Ultra-widefield (UWF) fundus image — 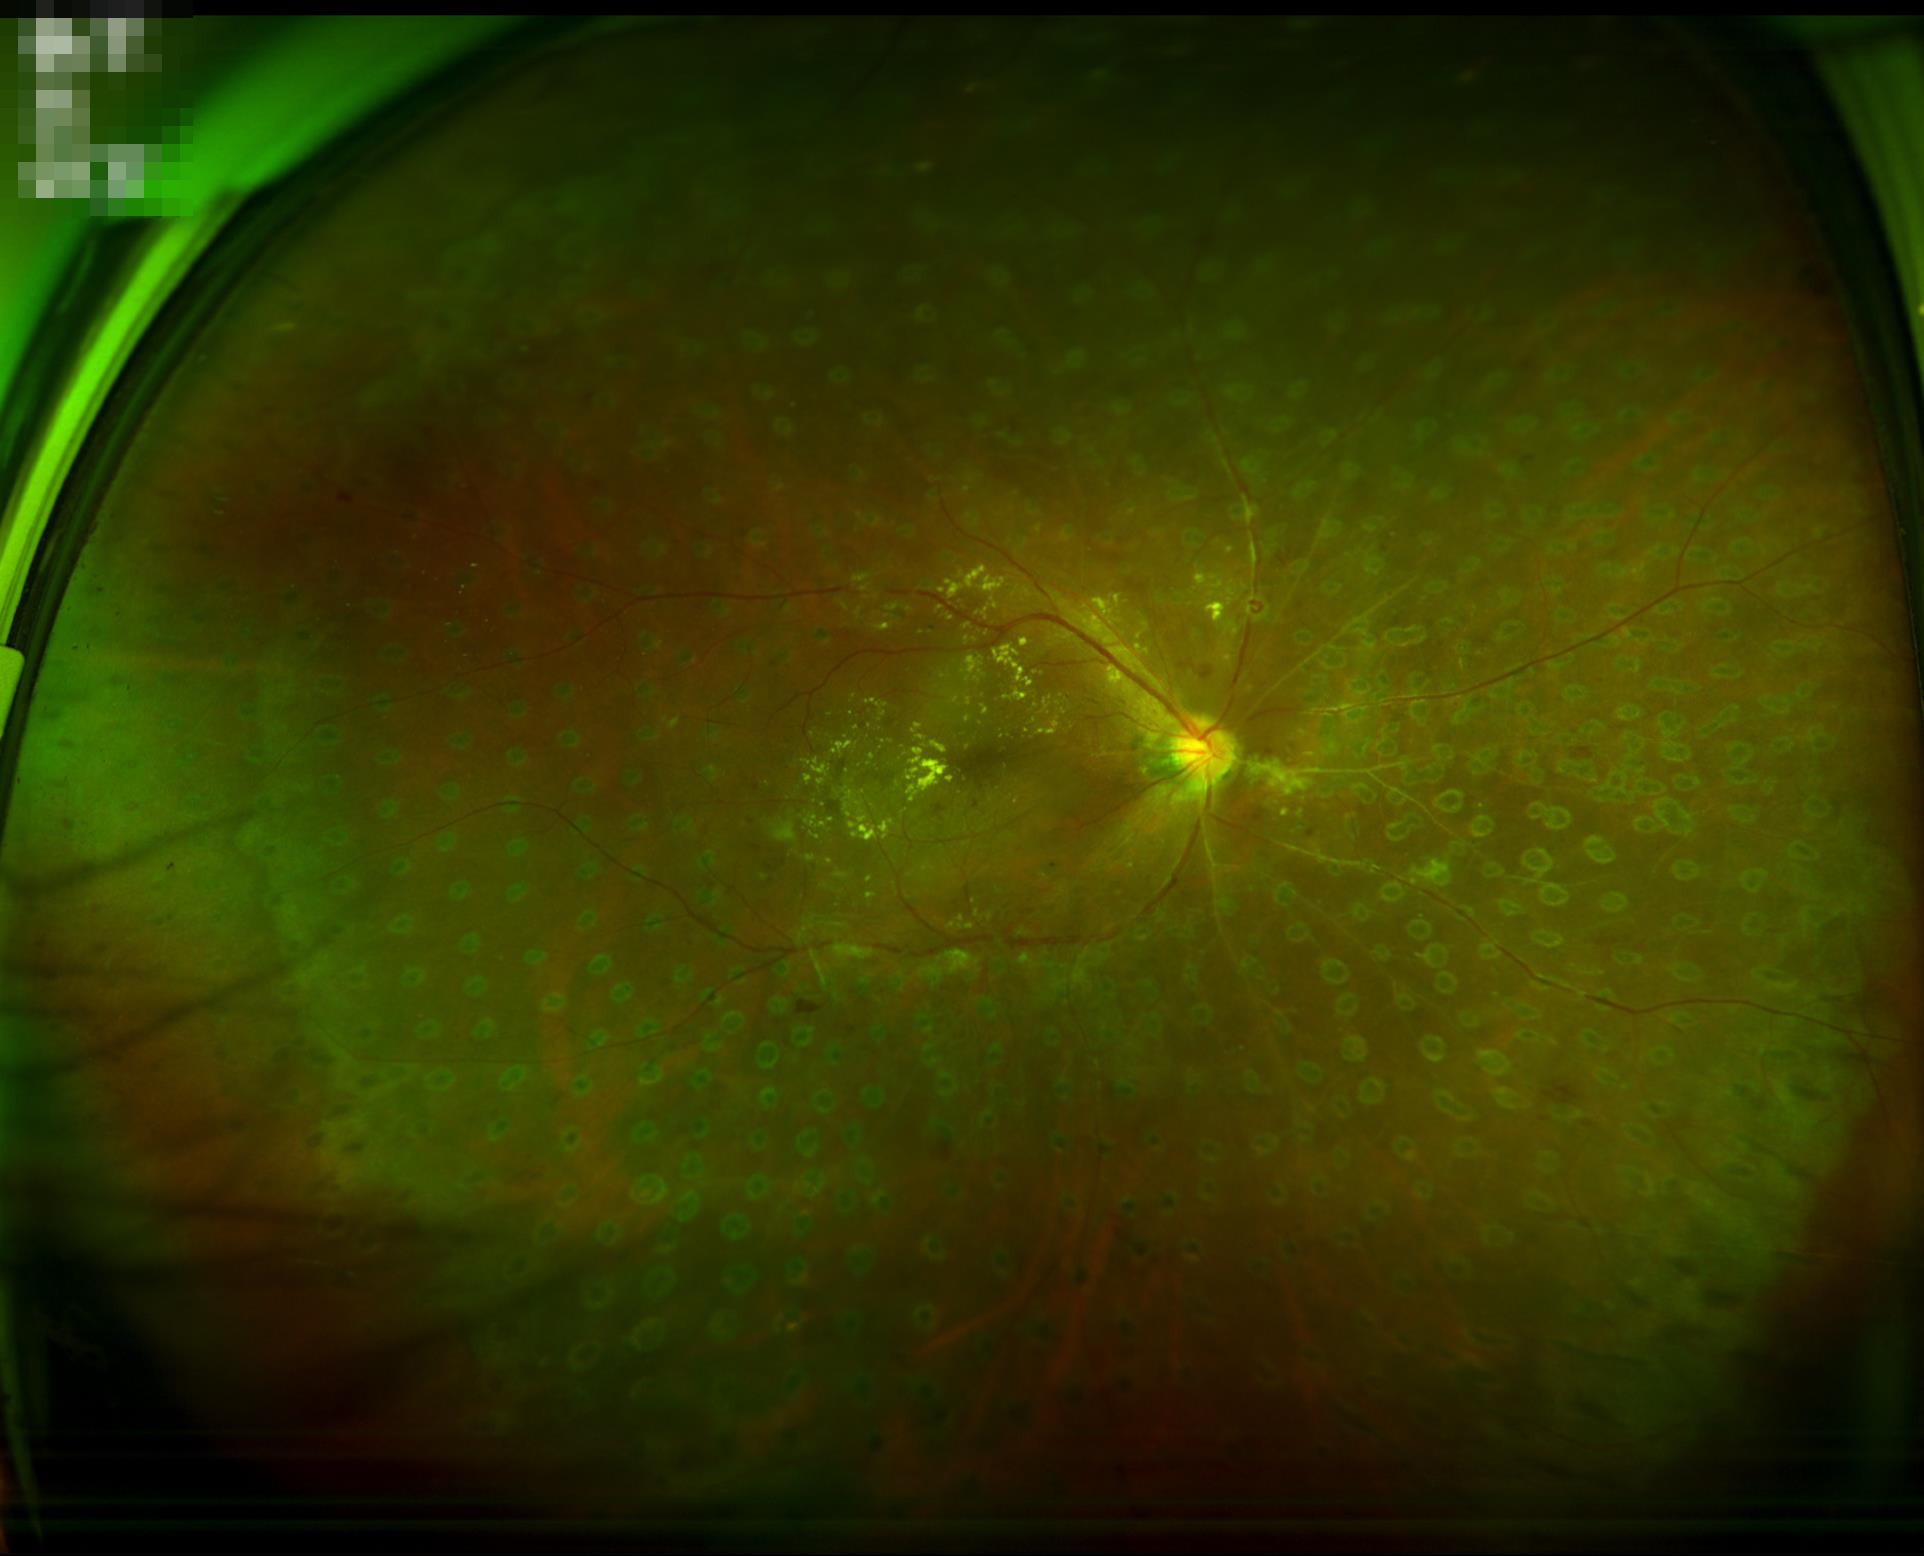
  overall_quality: good, gradable
  clarity: optic disc, vessels, and background in focus
  contrast: low, vessels and details hard to distinguish